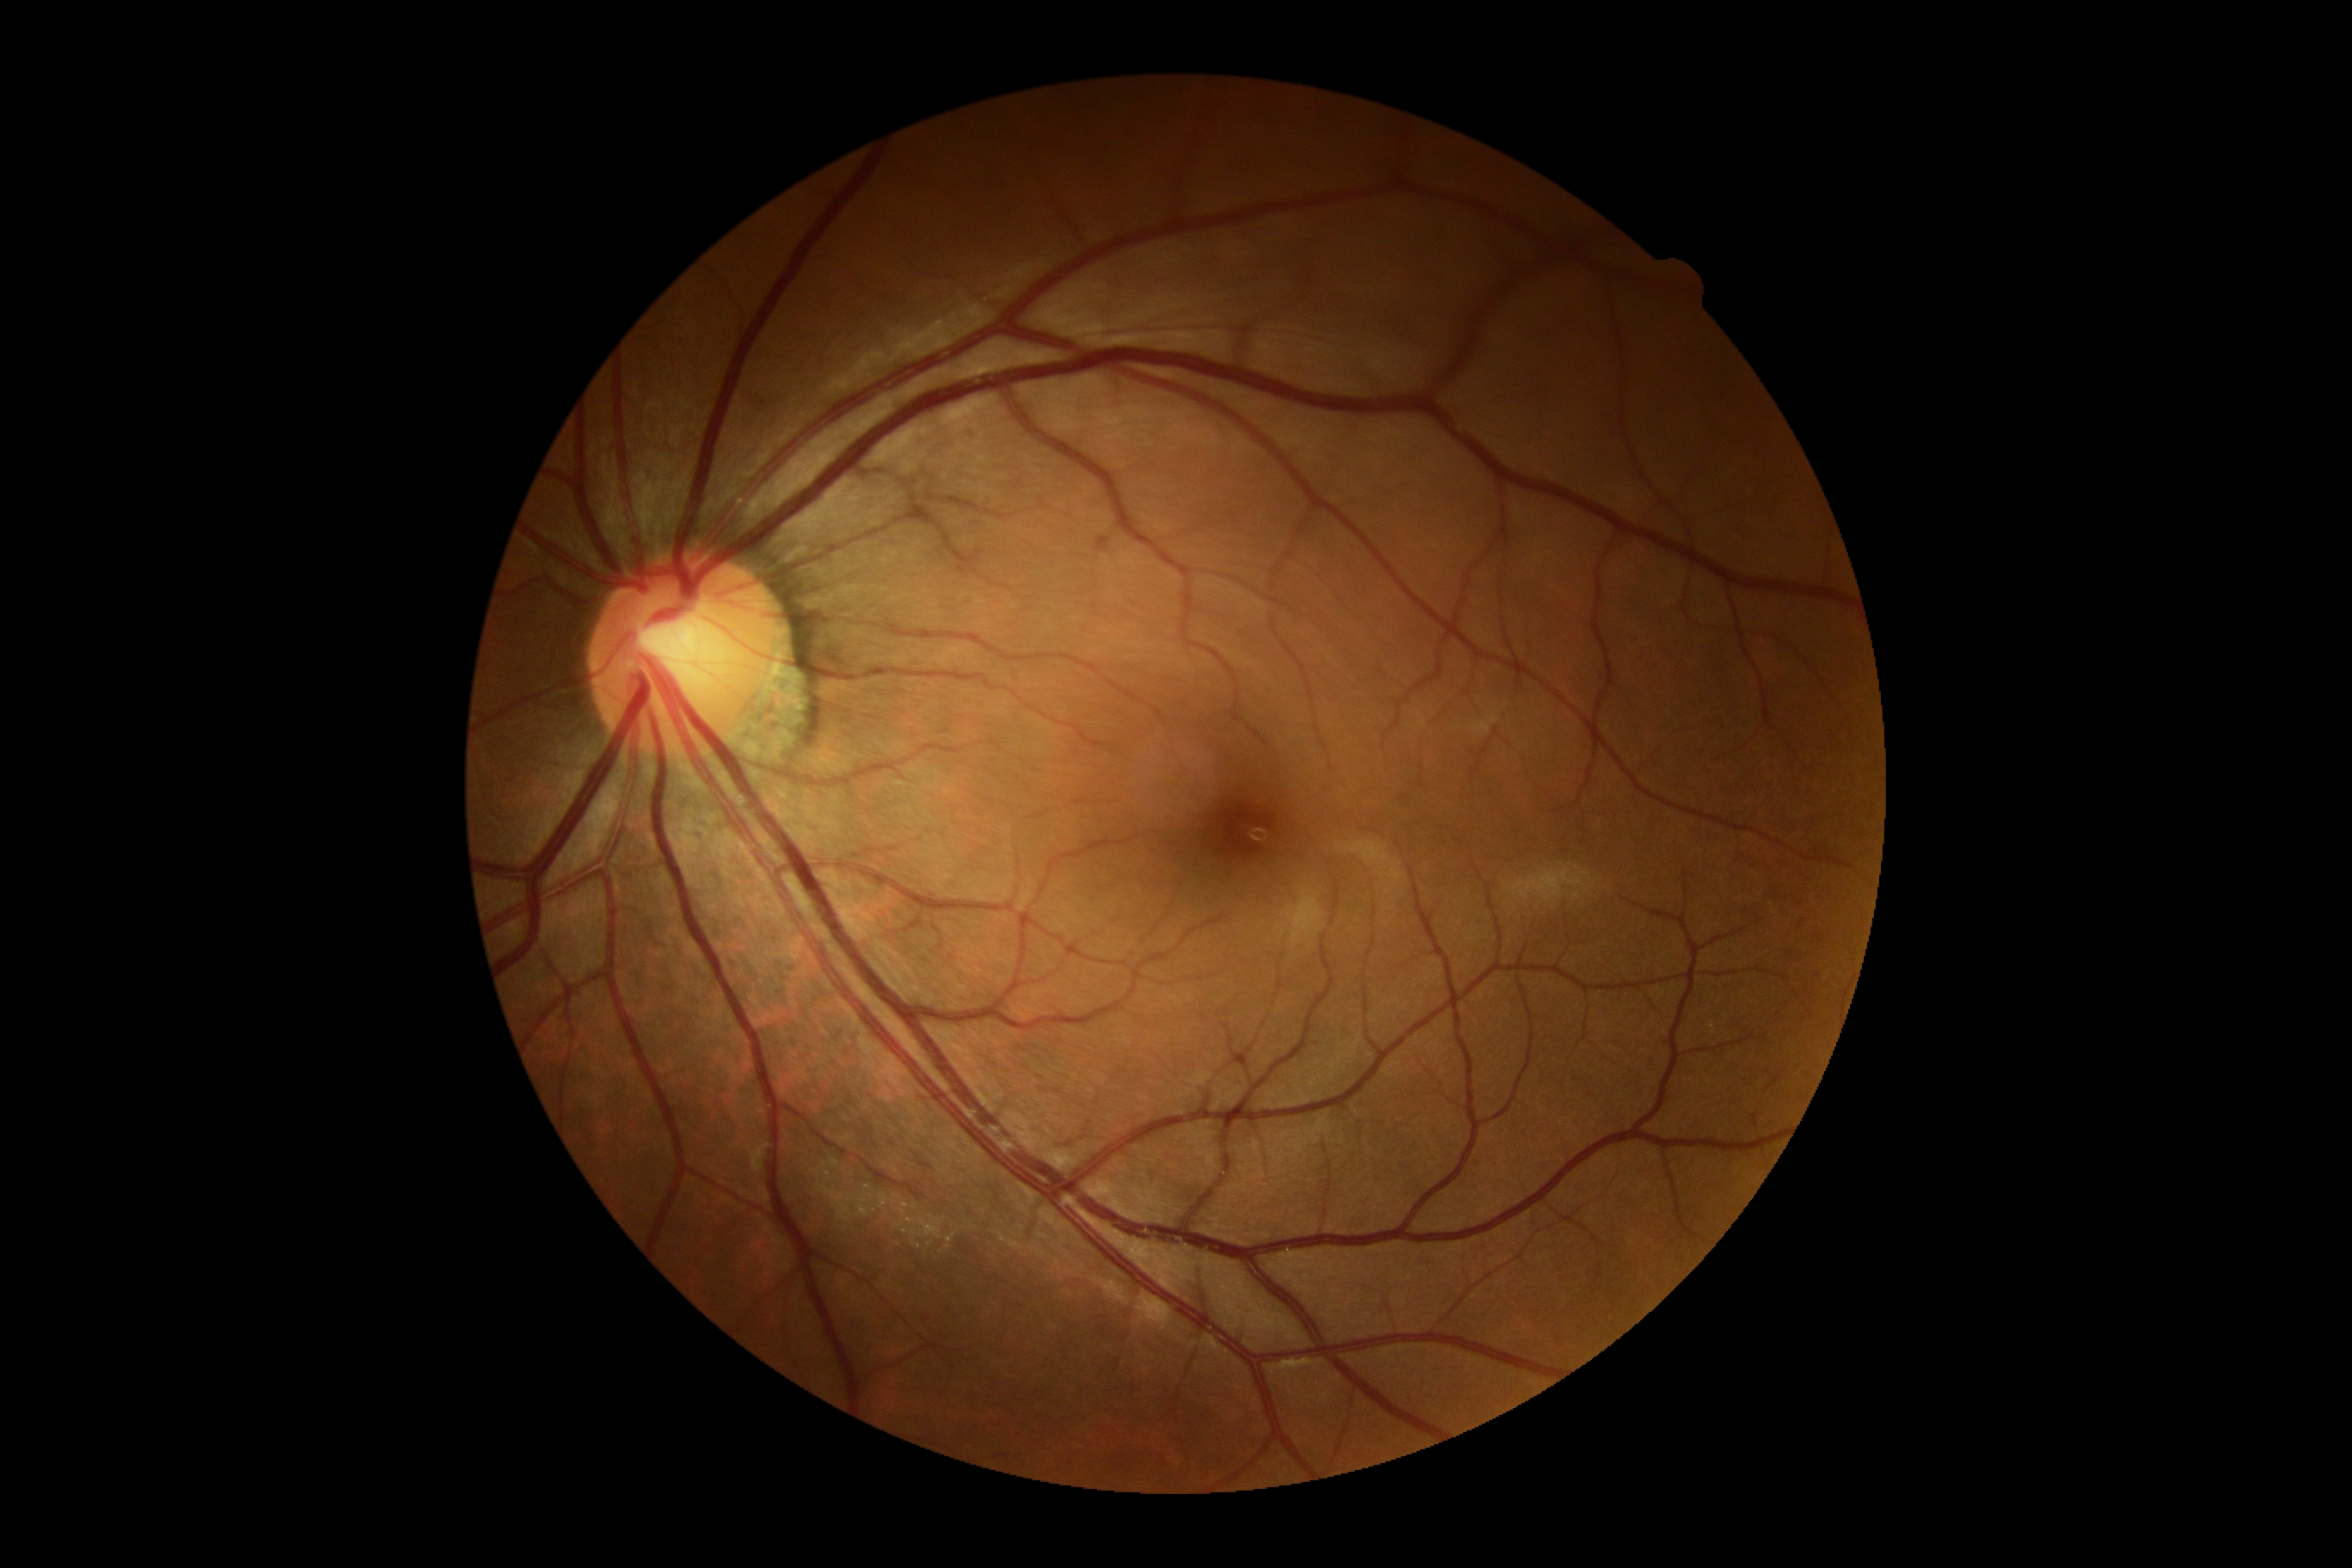

DR severity: 0.